Wide-field contact fundus photograph of an infant:
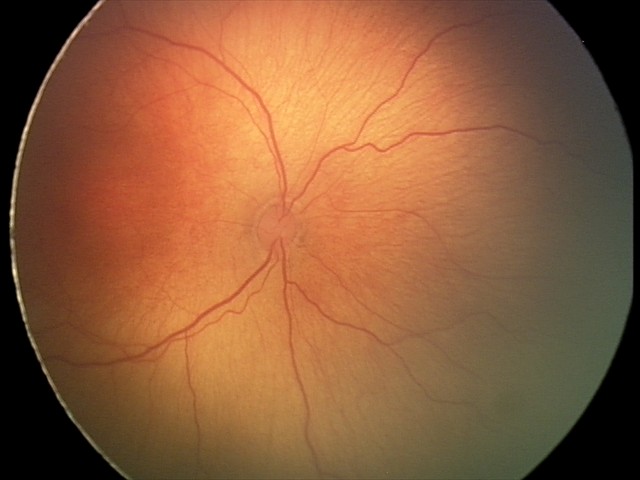

Examination diagnosed as retinopathy of prematurity stage 2 — ridge with height and width at the demarcation line. Without plus disease.